1240 by 1240 pixels; wide-field contact fundus photograph of an infant; acquired on the Phoenix ICON: 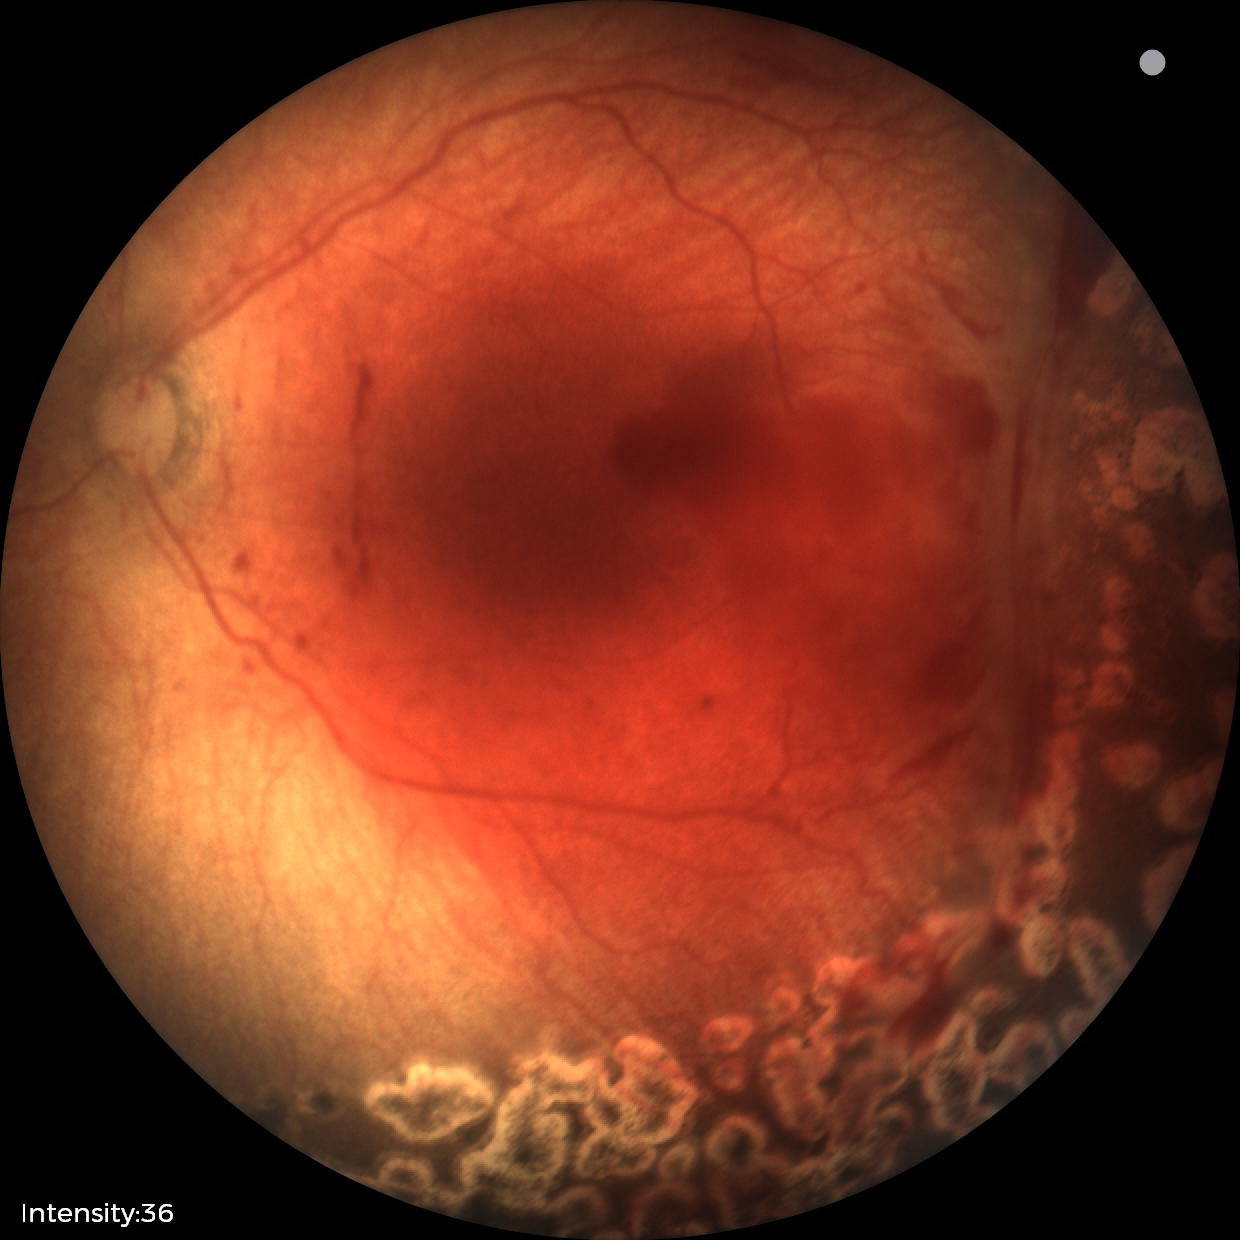

Plus disease = absent, screening diagnosis = status post retinopathy of prematurity.